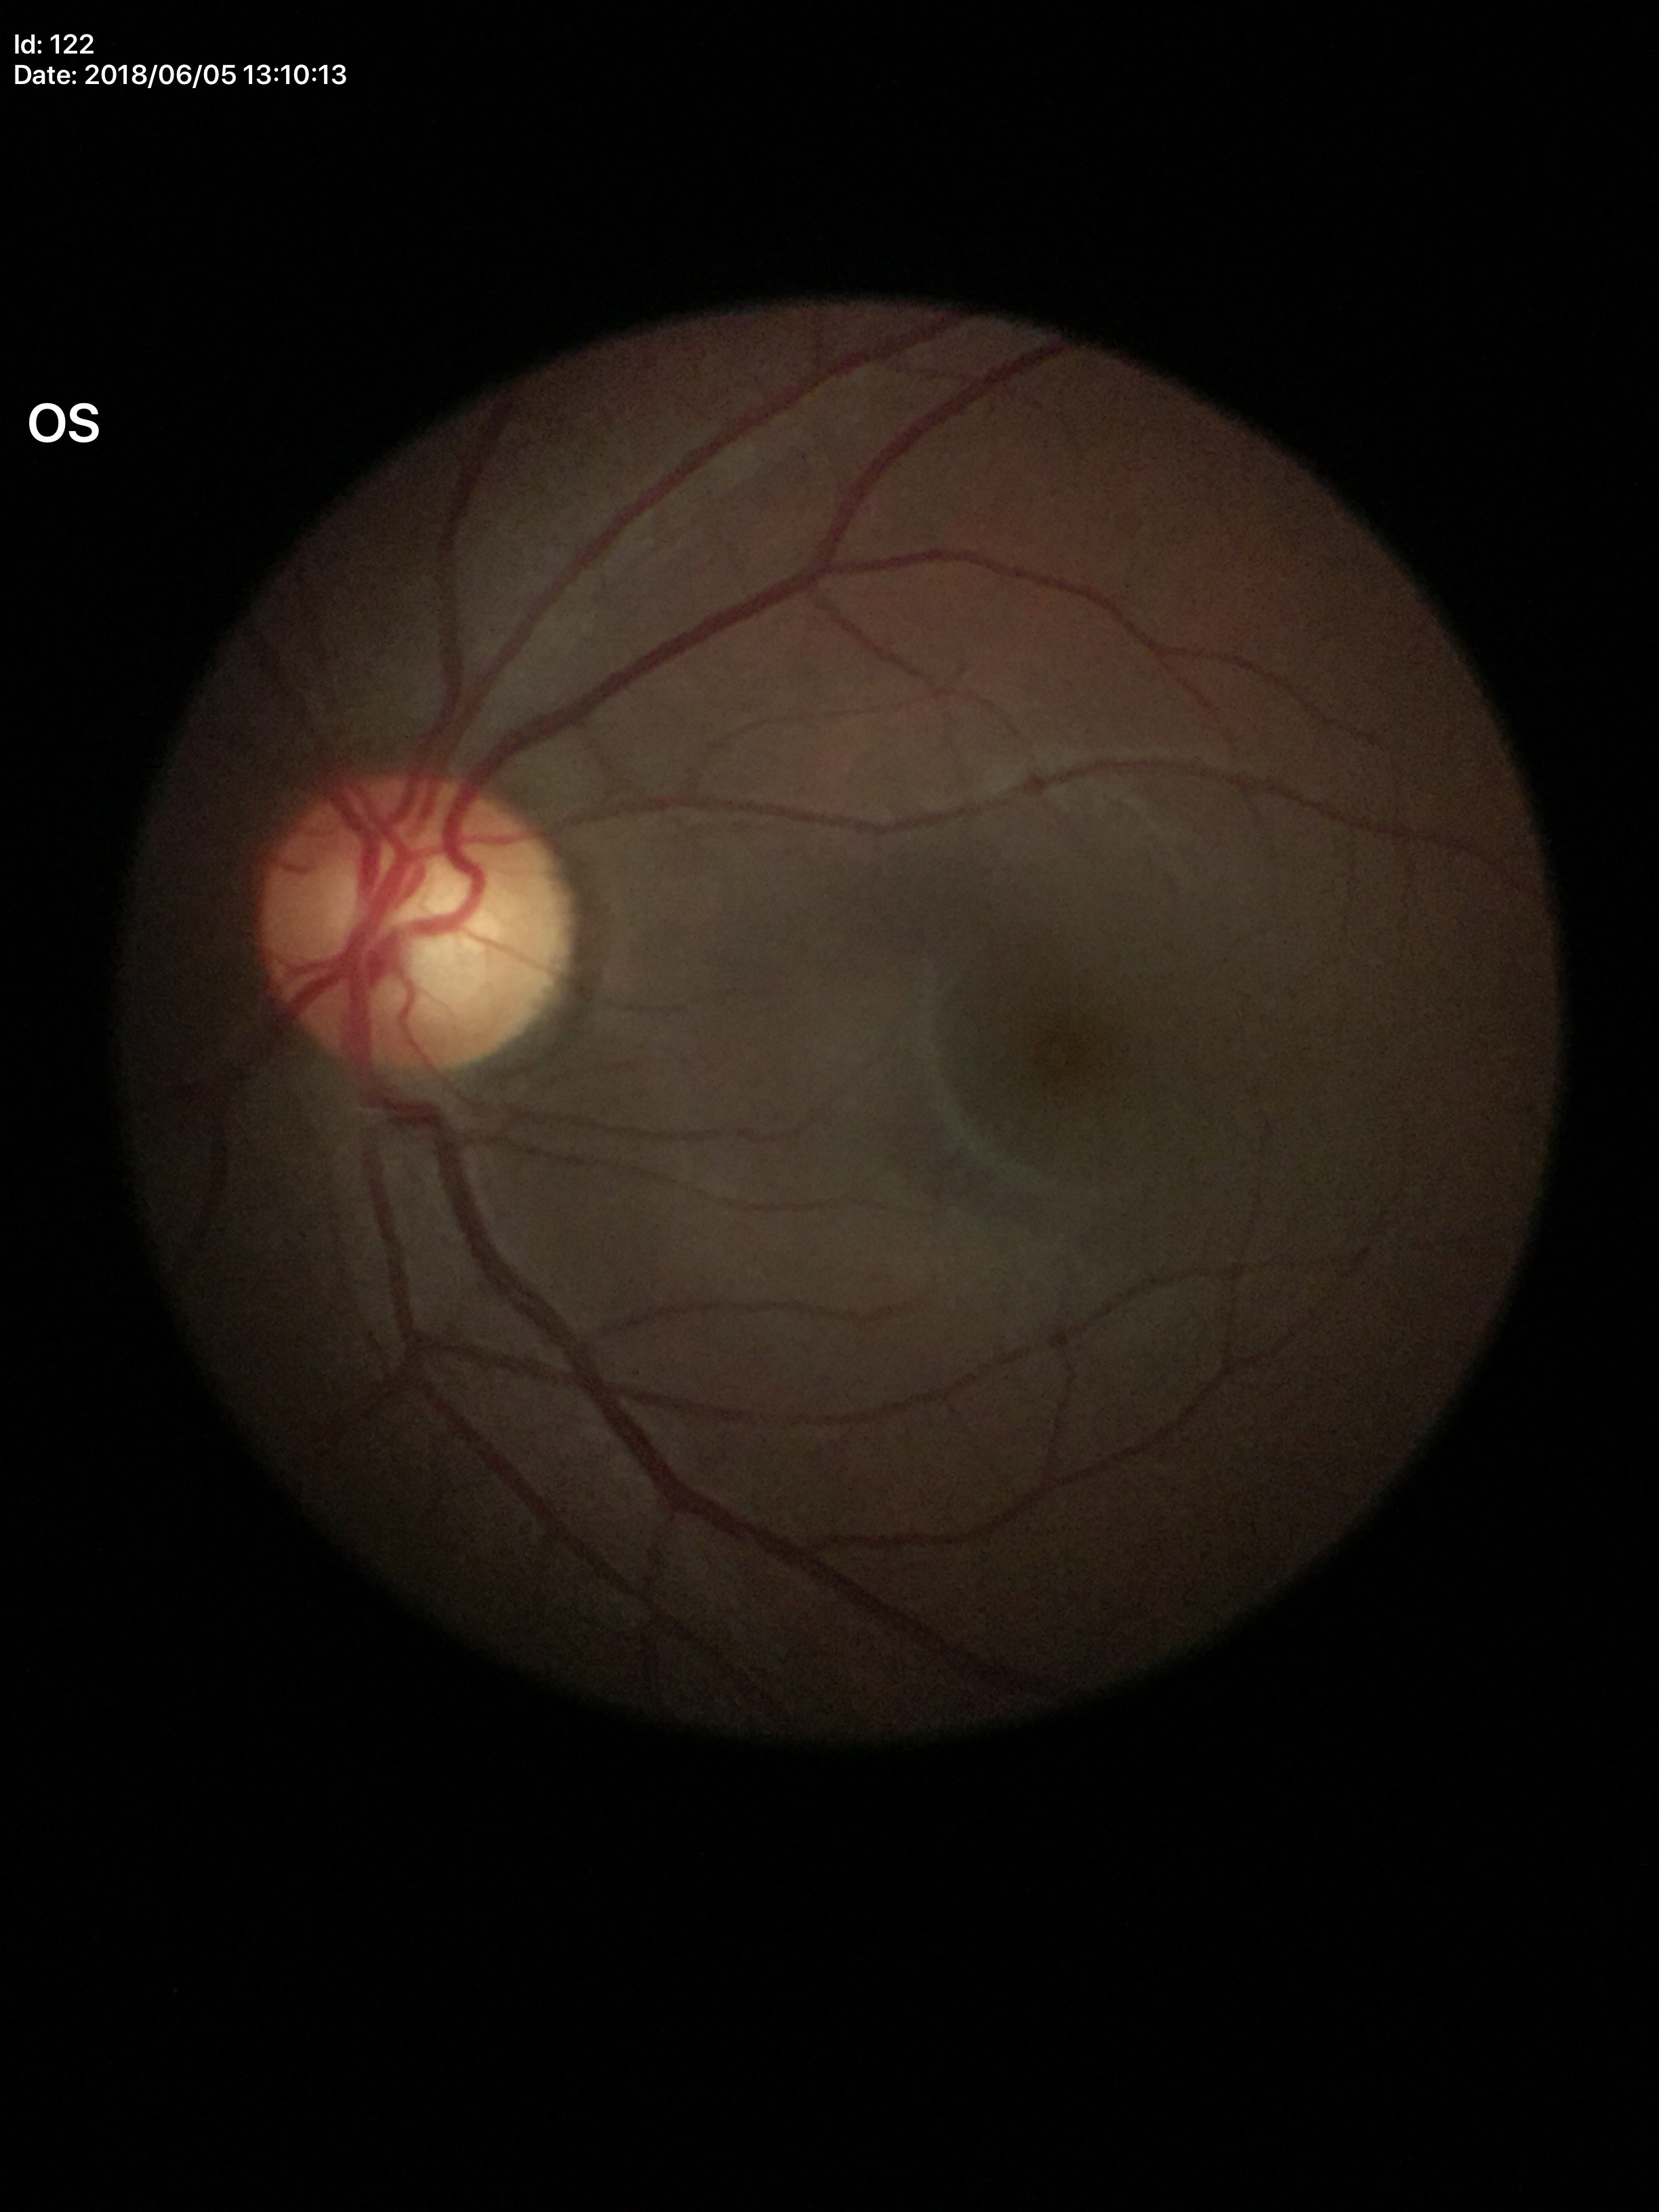 Glaucoma evaluation = no suspicious findings | vertical cup-to-disc ratio (VCDR) = 0.59.